Mydriatic (tropicamide and phenylephrine), 2228 by 1652 pixels — 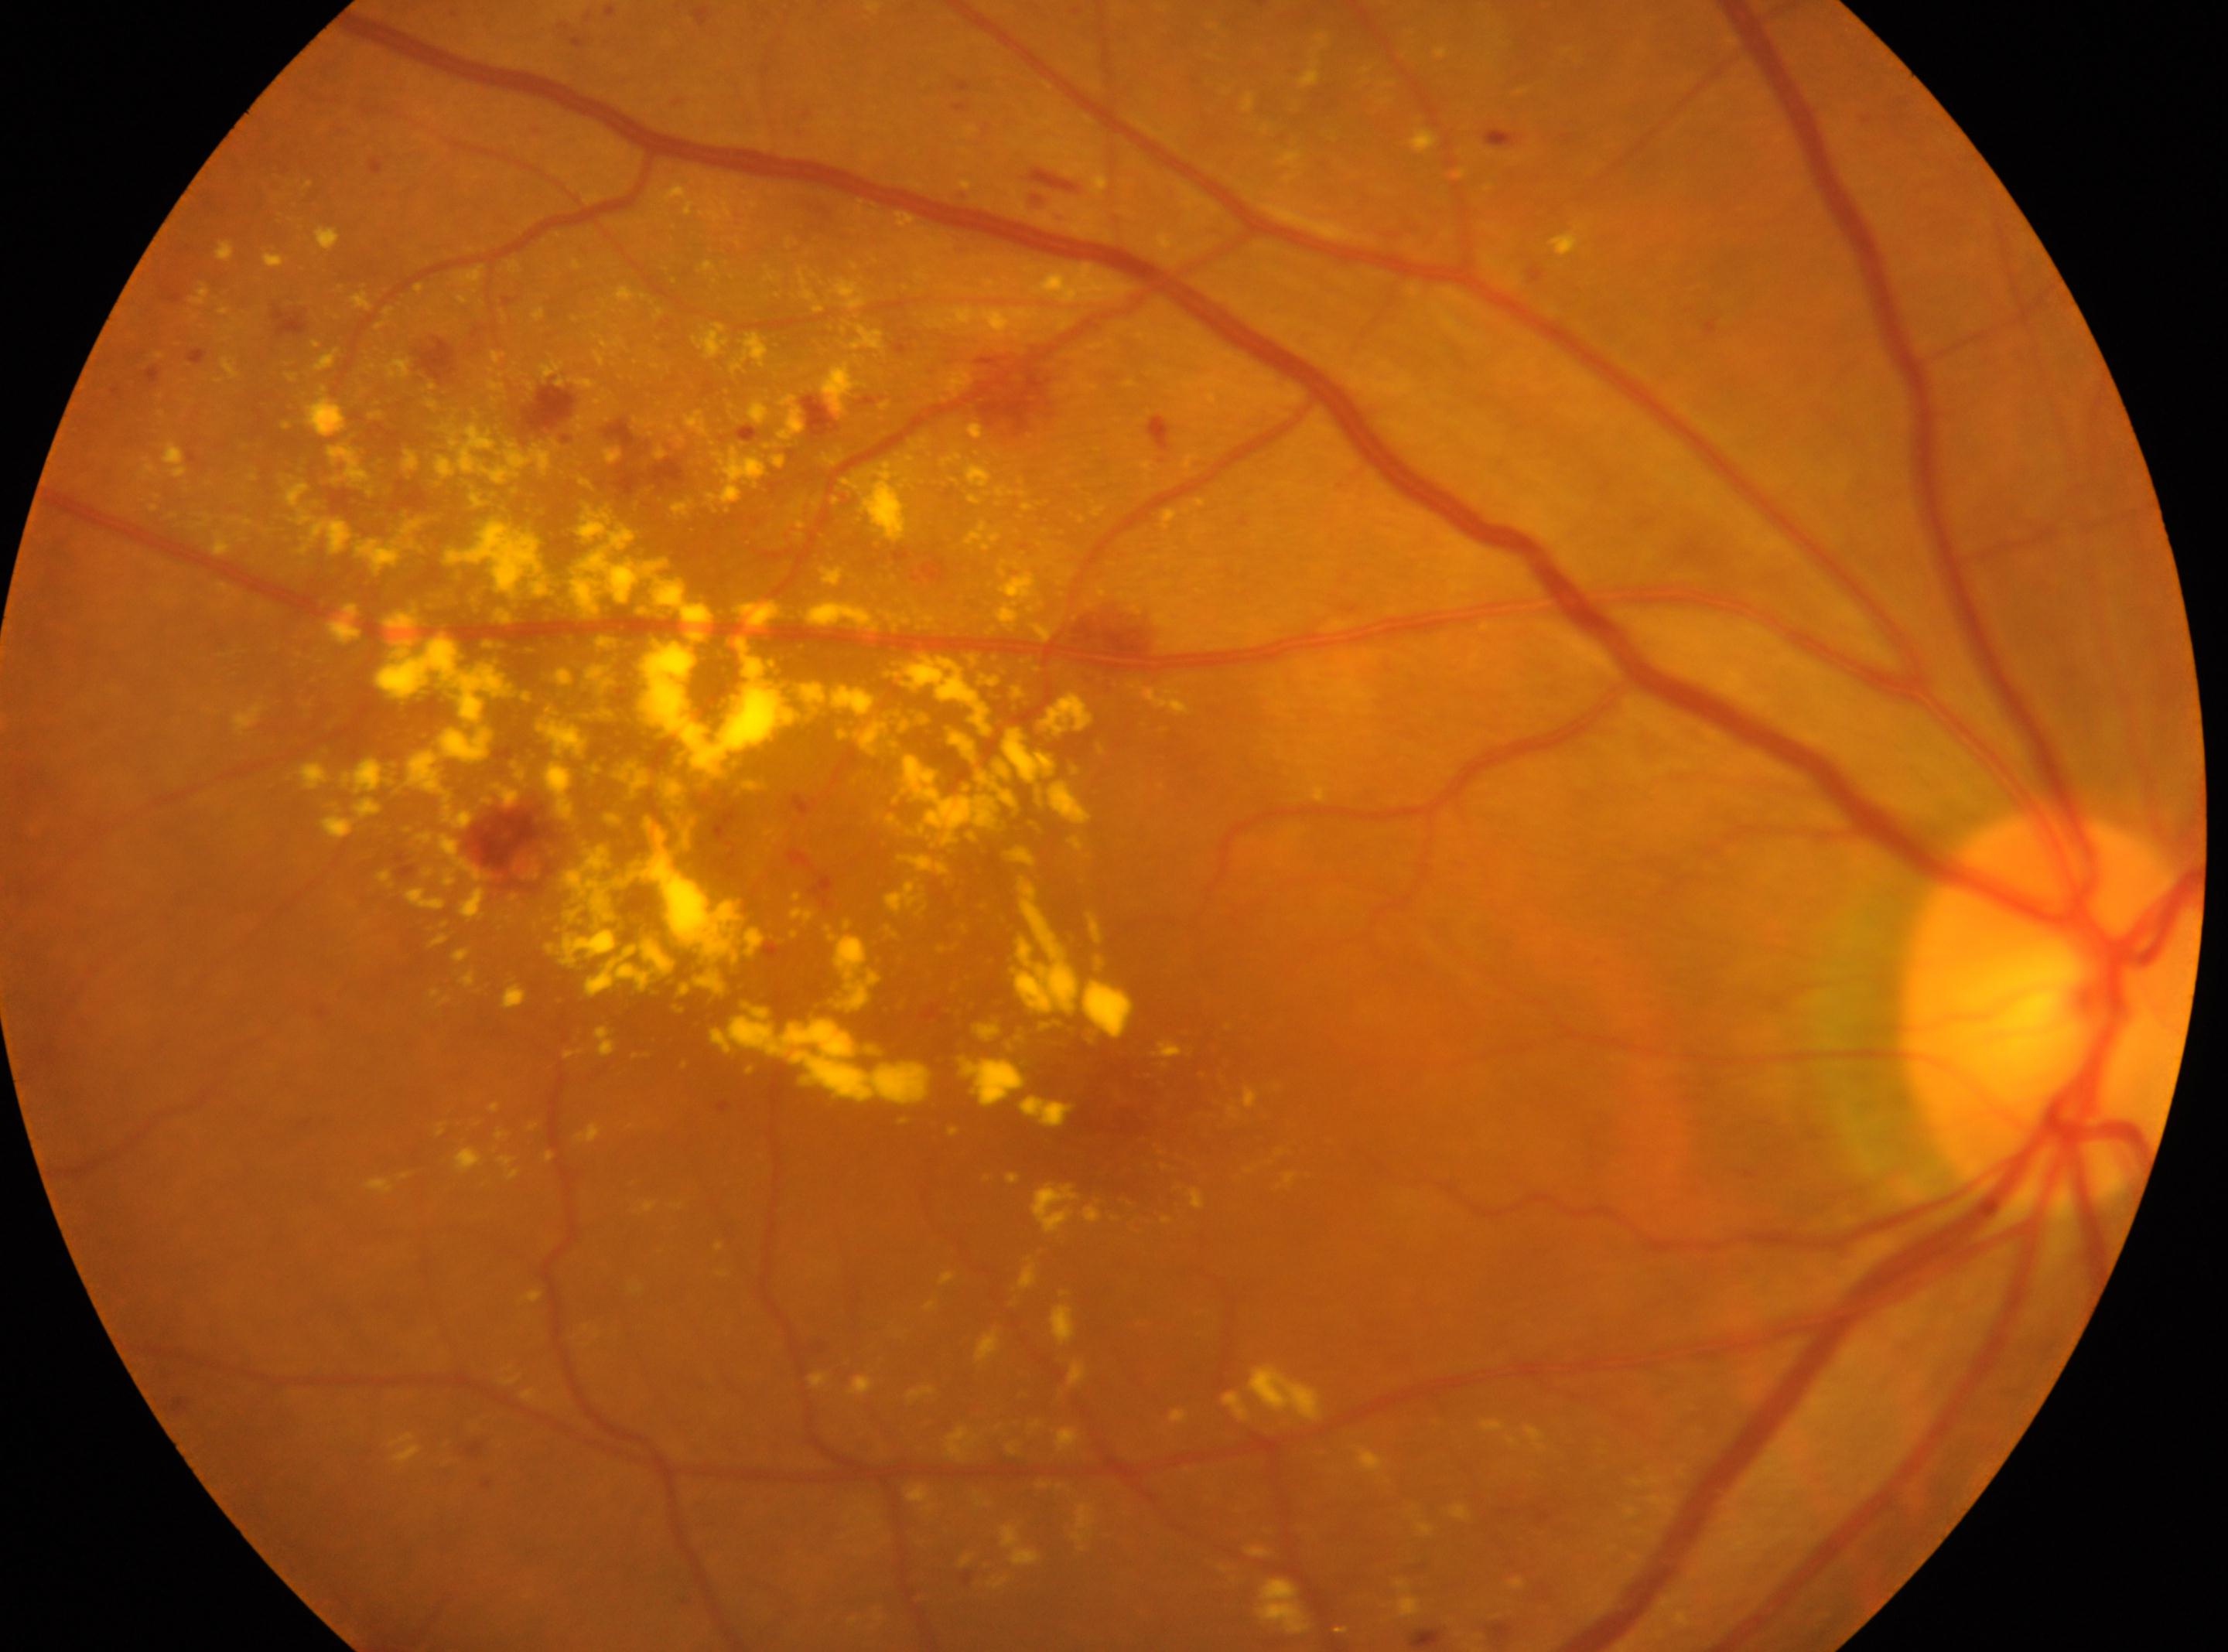 The macula center is at (x=1122, y=1112).
DR severity: grade 2.
Optic disc located at (x=2049, y=1012).
The image shows the oculus dexter.